Posterior pole color fundus photograph, no pharmacologic dilation — 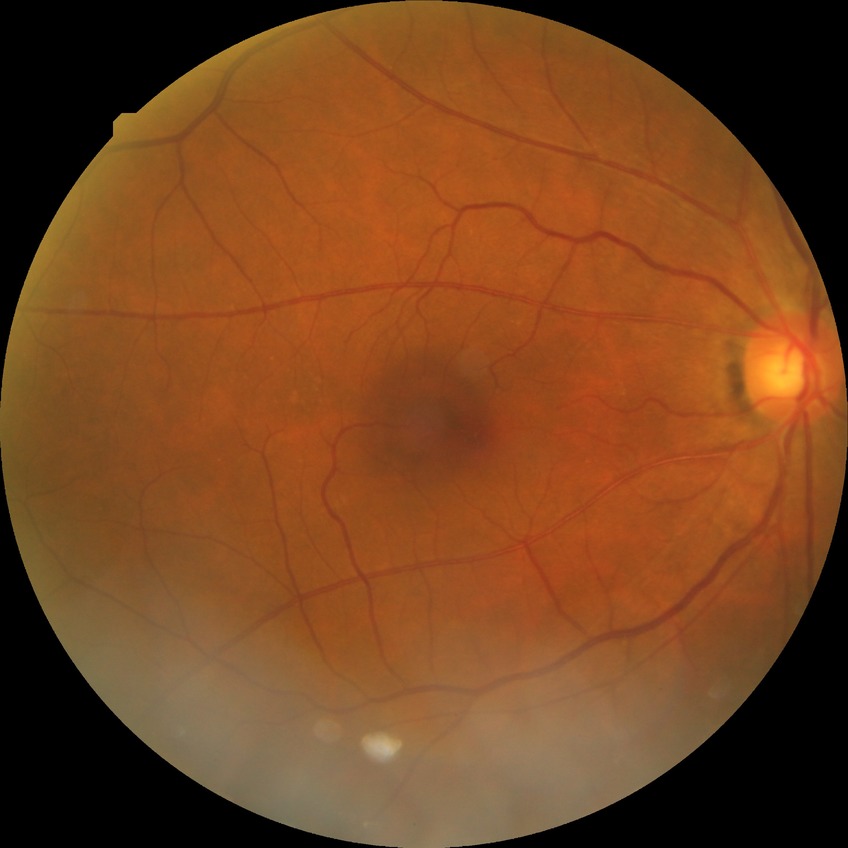
Davis grade is NDR.